Camera: Clarity RetCam 3 (130° FOV); wide-field fundus photograph of an infant:
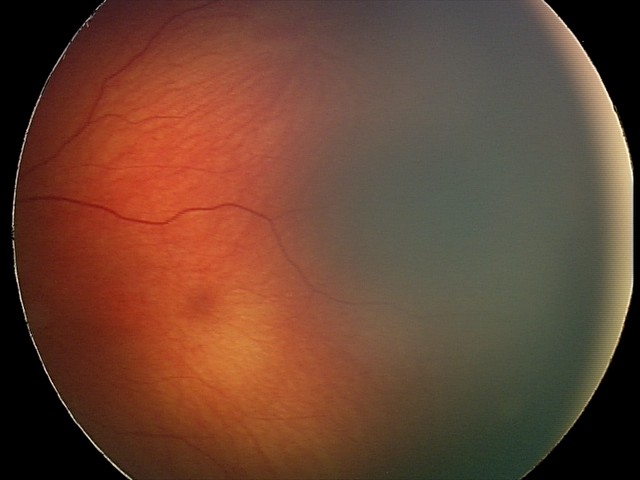

Diagnosis from this screening exam: retinal hemorrhages.